1659x2212px, acquired with a Remidio smartphone fundus camera, retinal fundus photograph
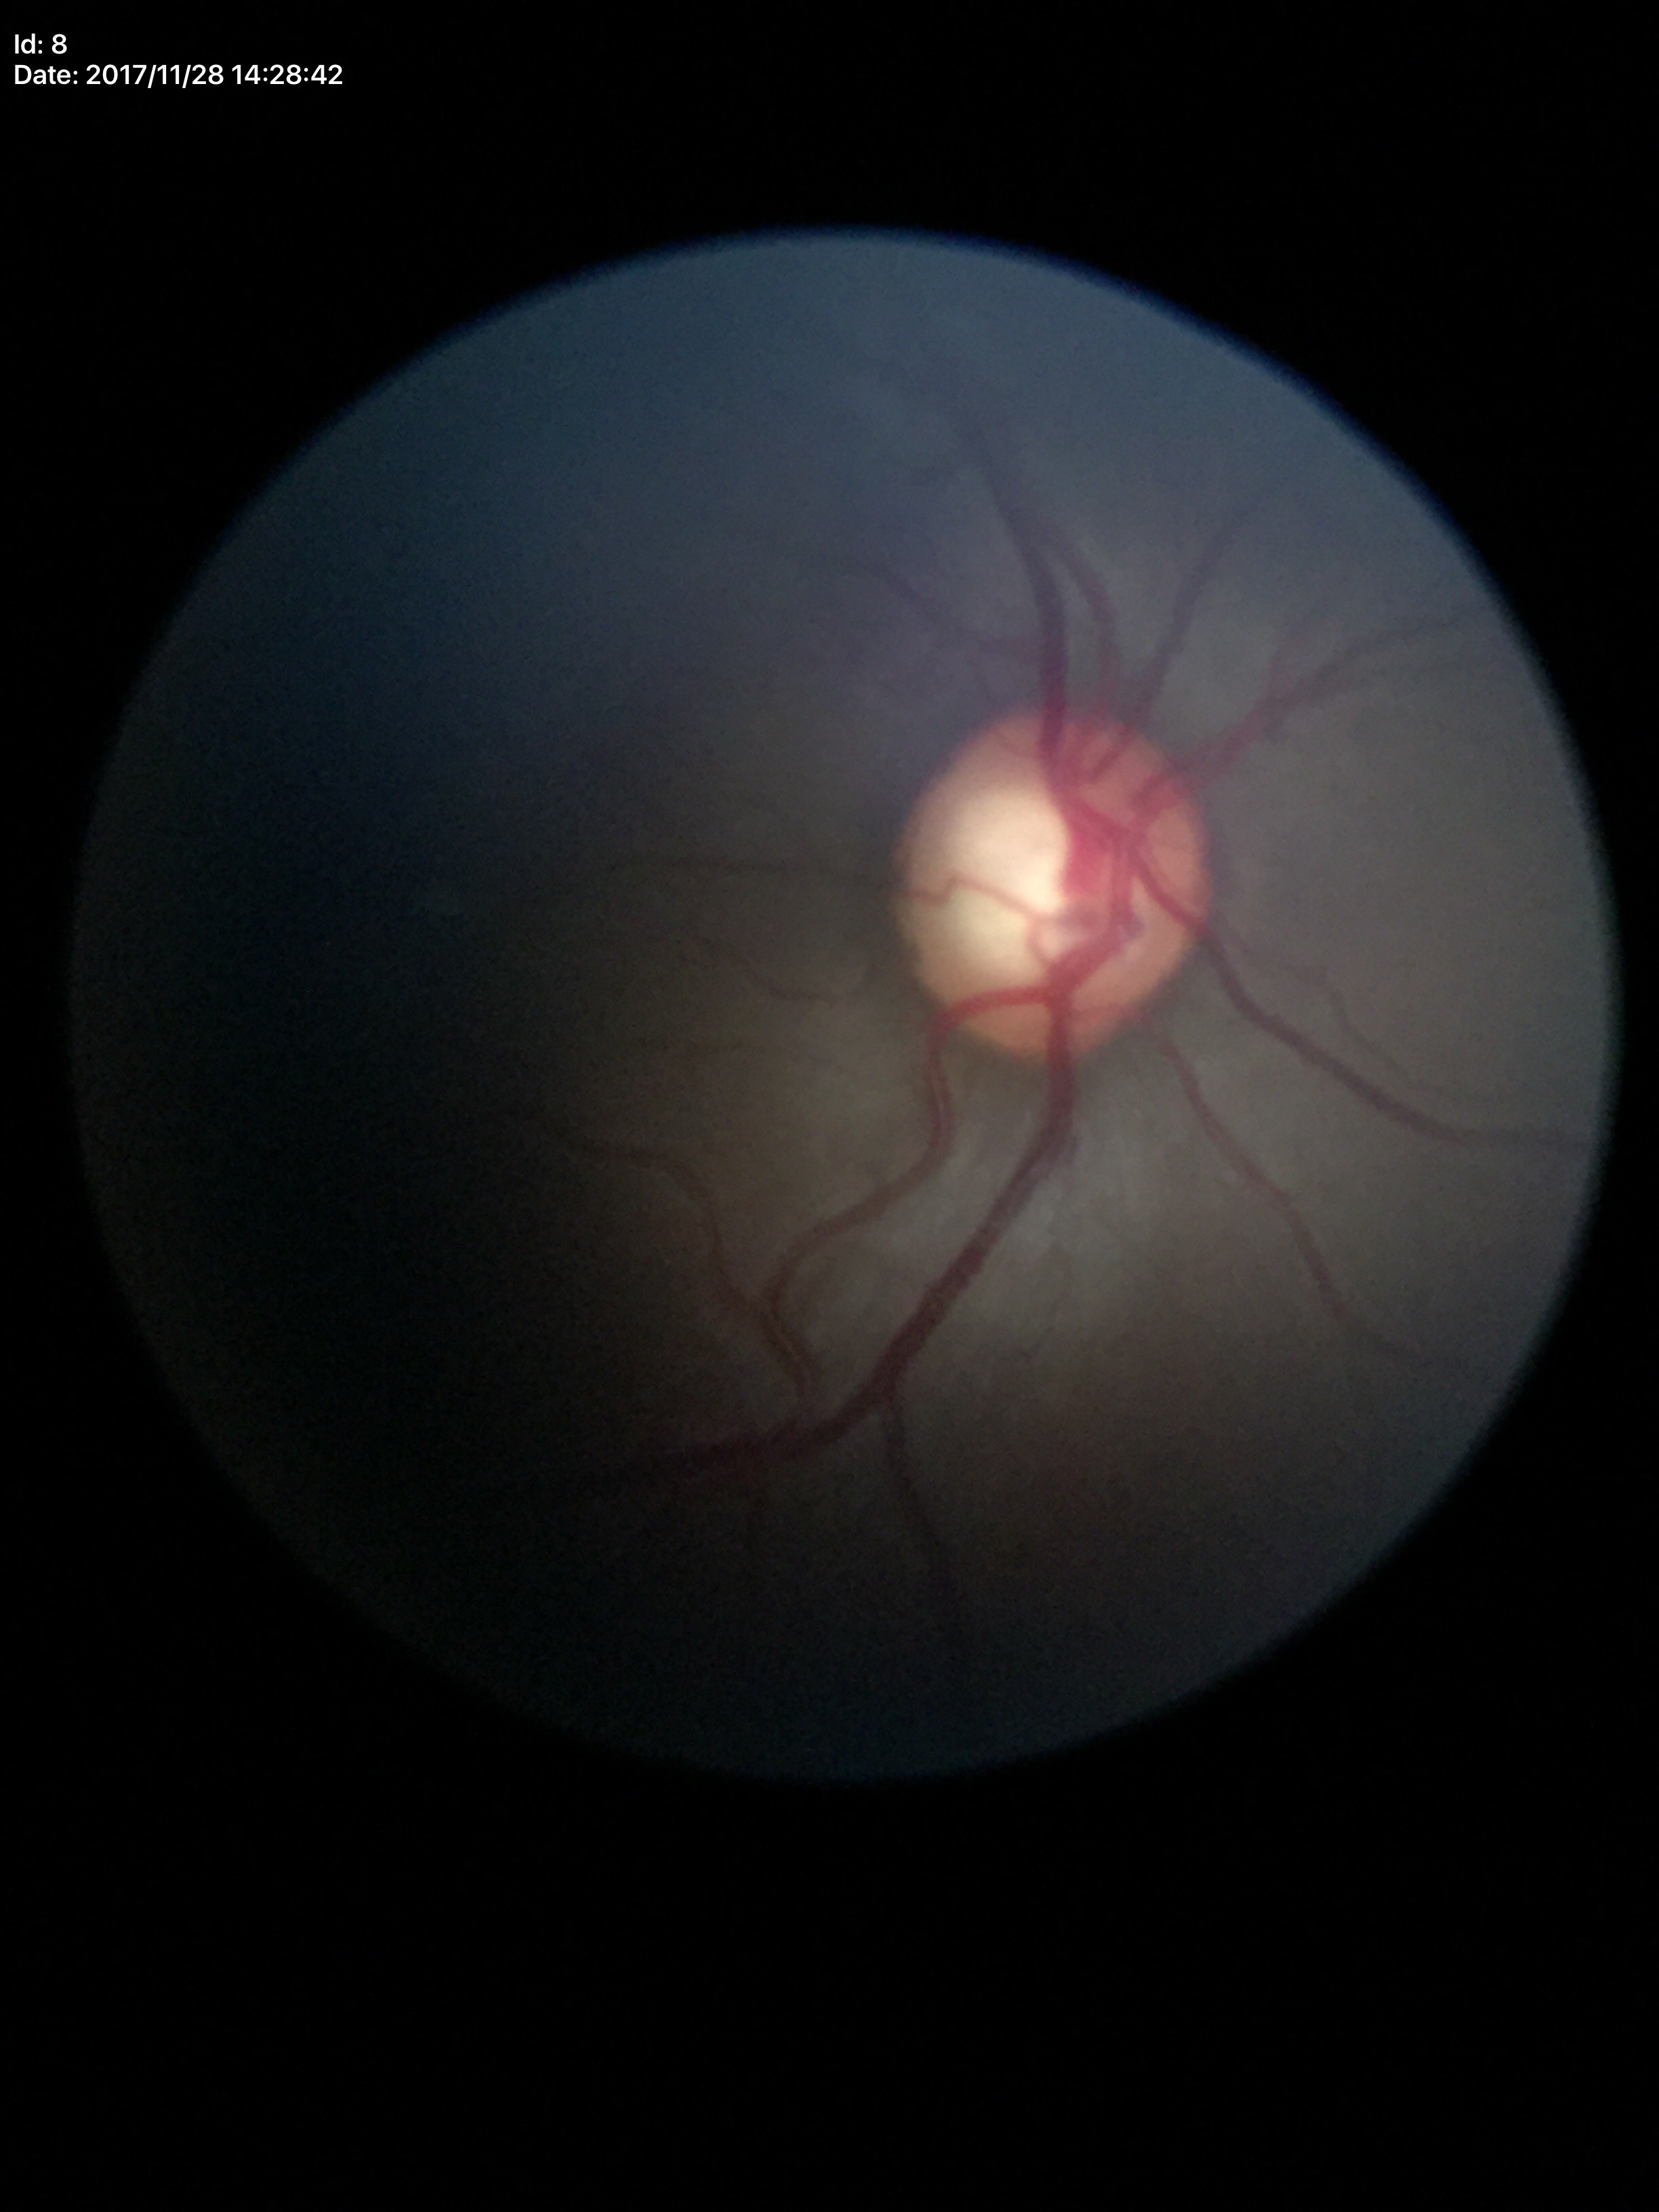

horizontal CDR: 0.65; area C/D ratio: 0.41; vertical cup-to-disc ratio: 0.62; Glaucoma impression: suspicious findings.